Color fundus photograph. Disc-centered field — 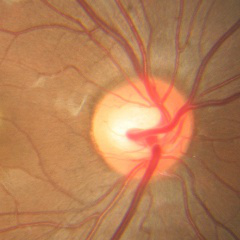

Diagnosis = no glaucomatous findings.